RetCam wide-field infant fundus image.
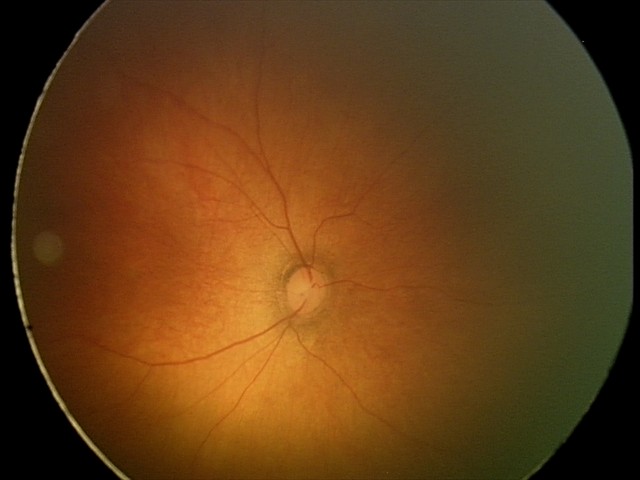
Examination with physiological retinal findings.